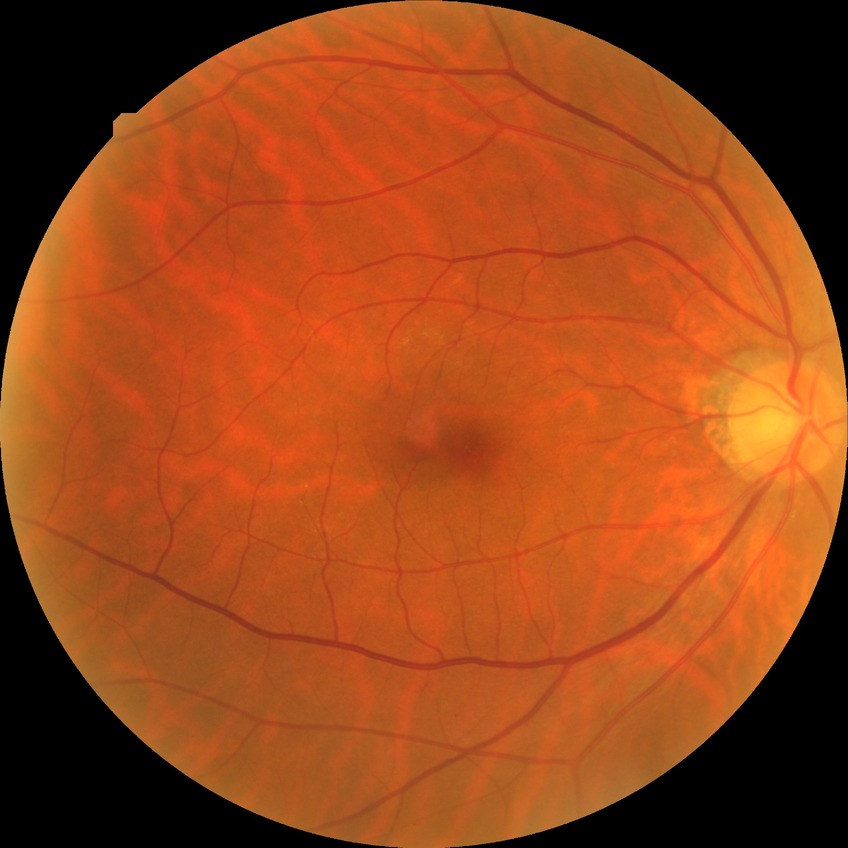
  dr_impression: negative for DR
  davis_grade: NDR